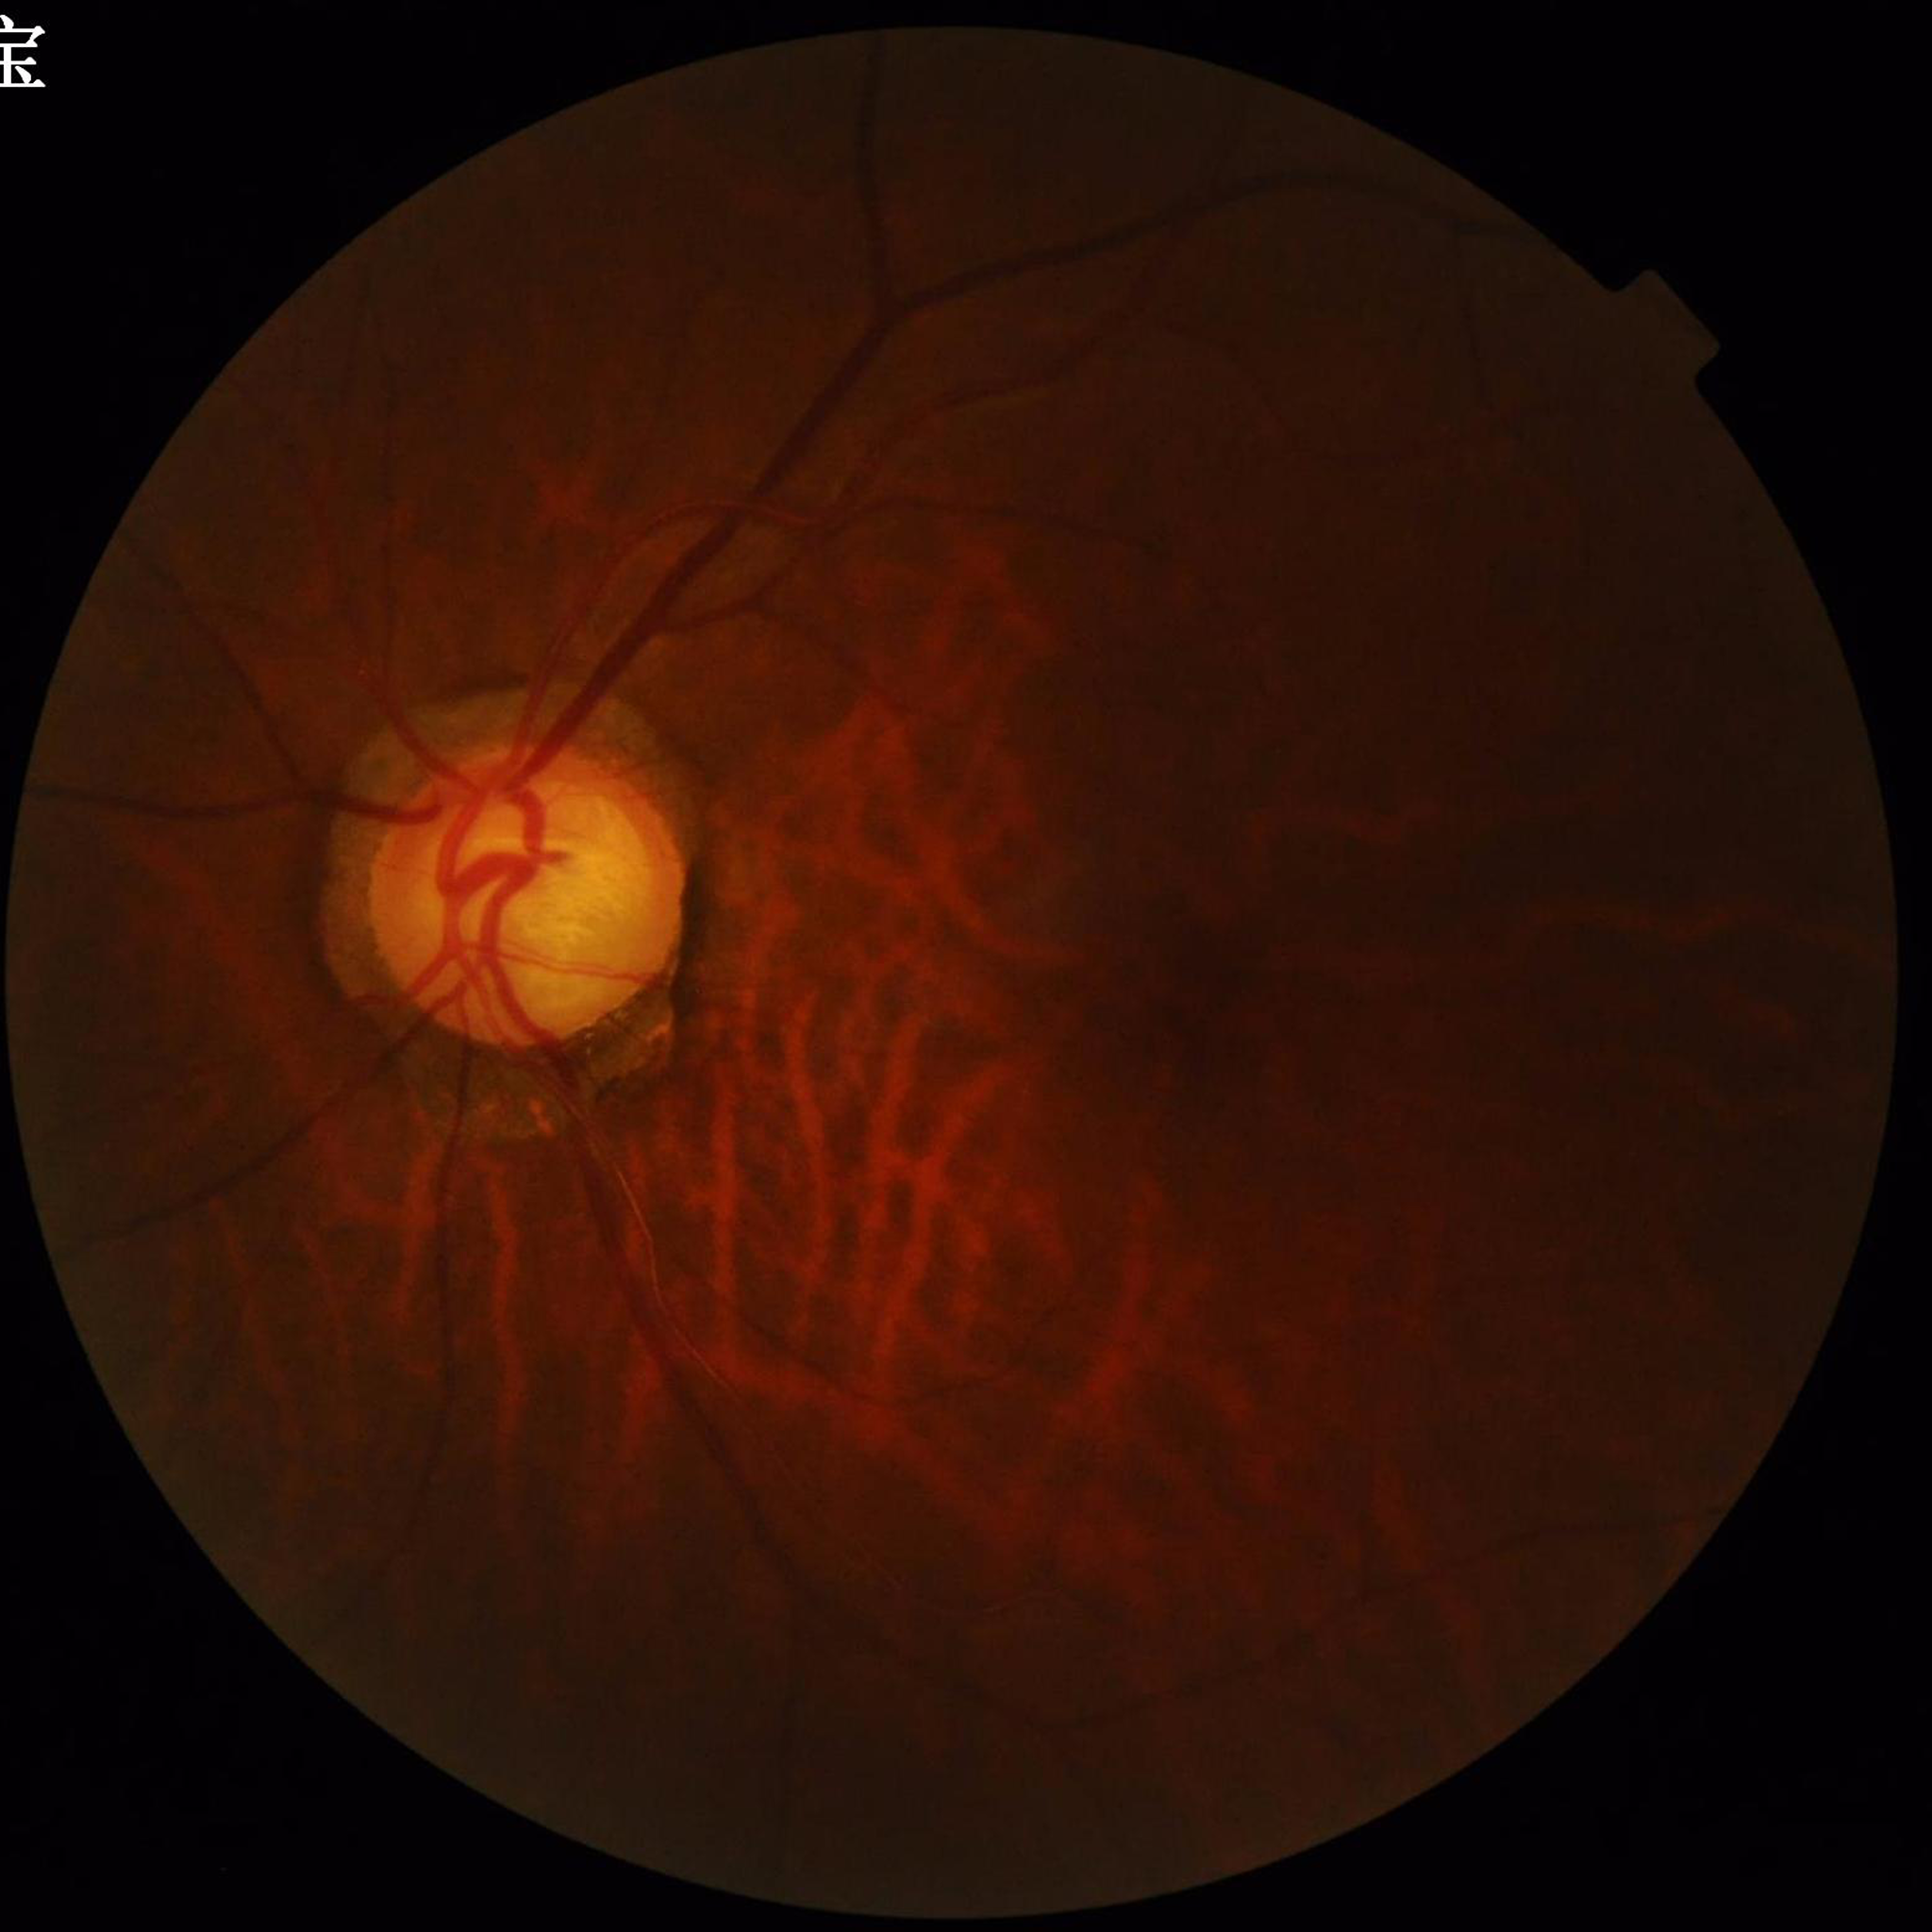
Quality assessment: concerns include blur, illumination/color distortion; Disease: glaucoma.